Captured after pupil dilation.
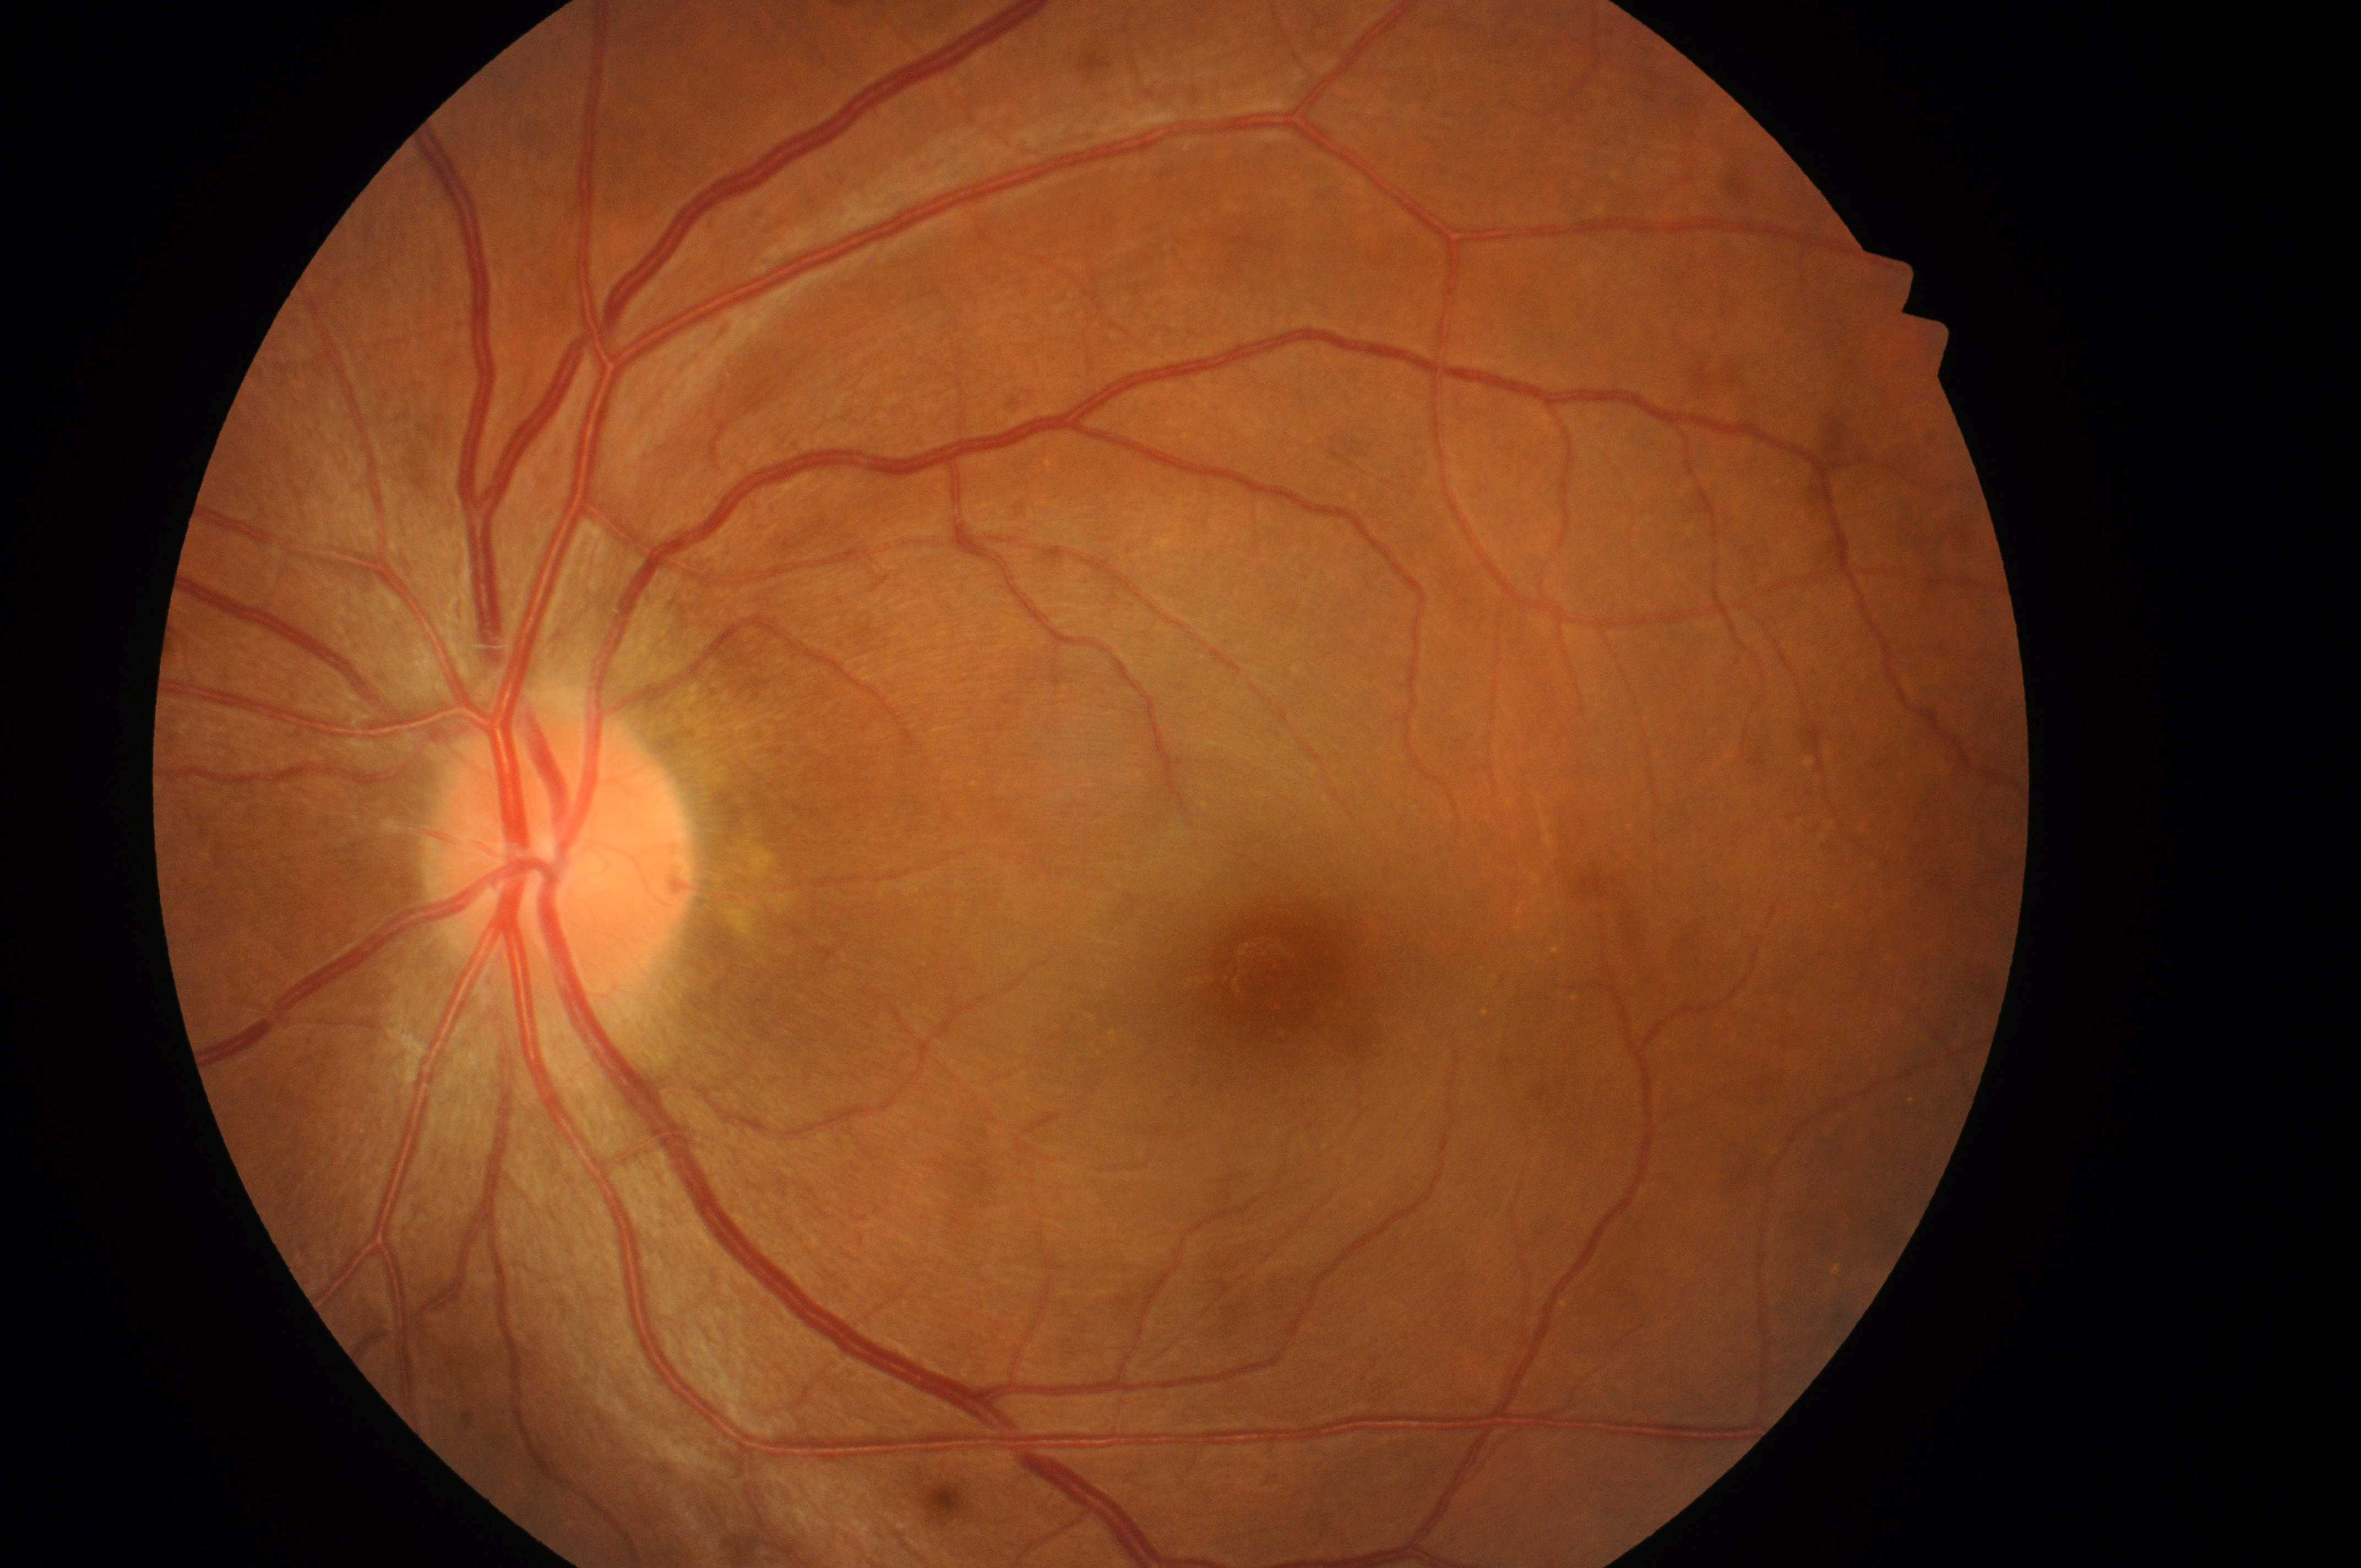

– DR impression · No DR or DME findings
– macular edema risk · no risk (grade 0)
– diabetic retinopathy · no apparent diabetic retinopathy (grade 0)
– optic nerve head · 559px, 864px
– fovea centralis · 1285px, 969px
– laterality · the left eye